Image size 848x848; nonmydriatic fundus photograph; color fundus image; FOV: 45 degrees — 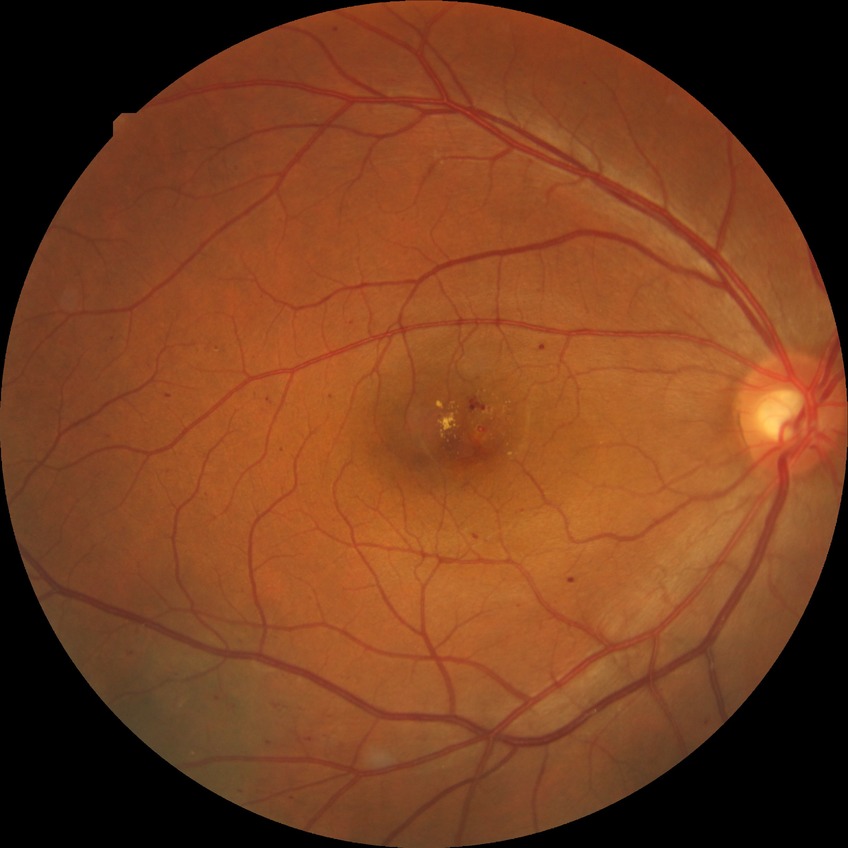
{
  "davis_grade": "SDR"
}